Color fundus image, macula-centered: 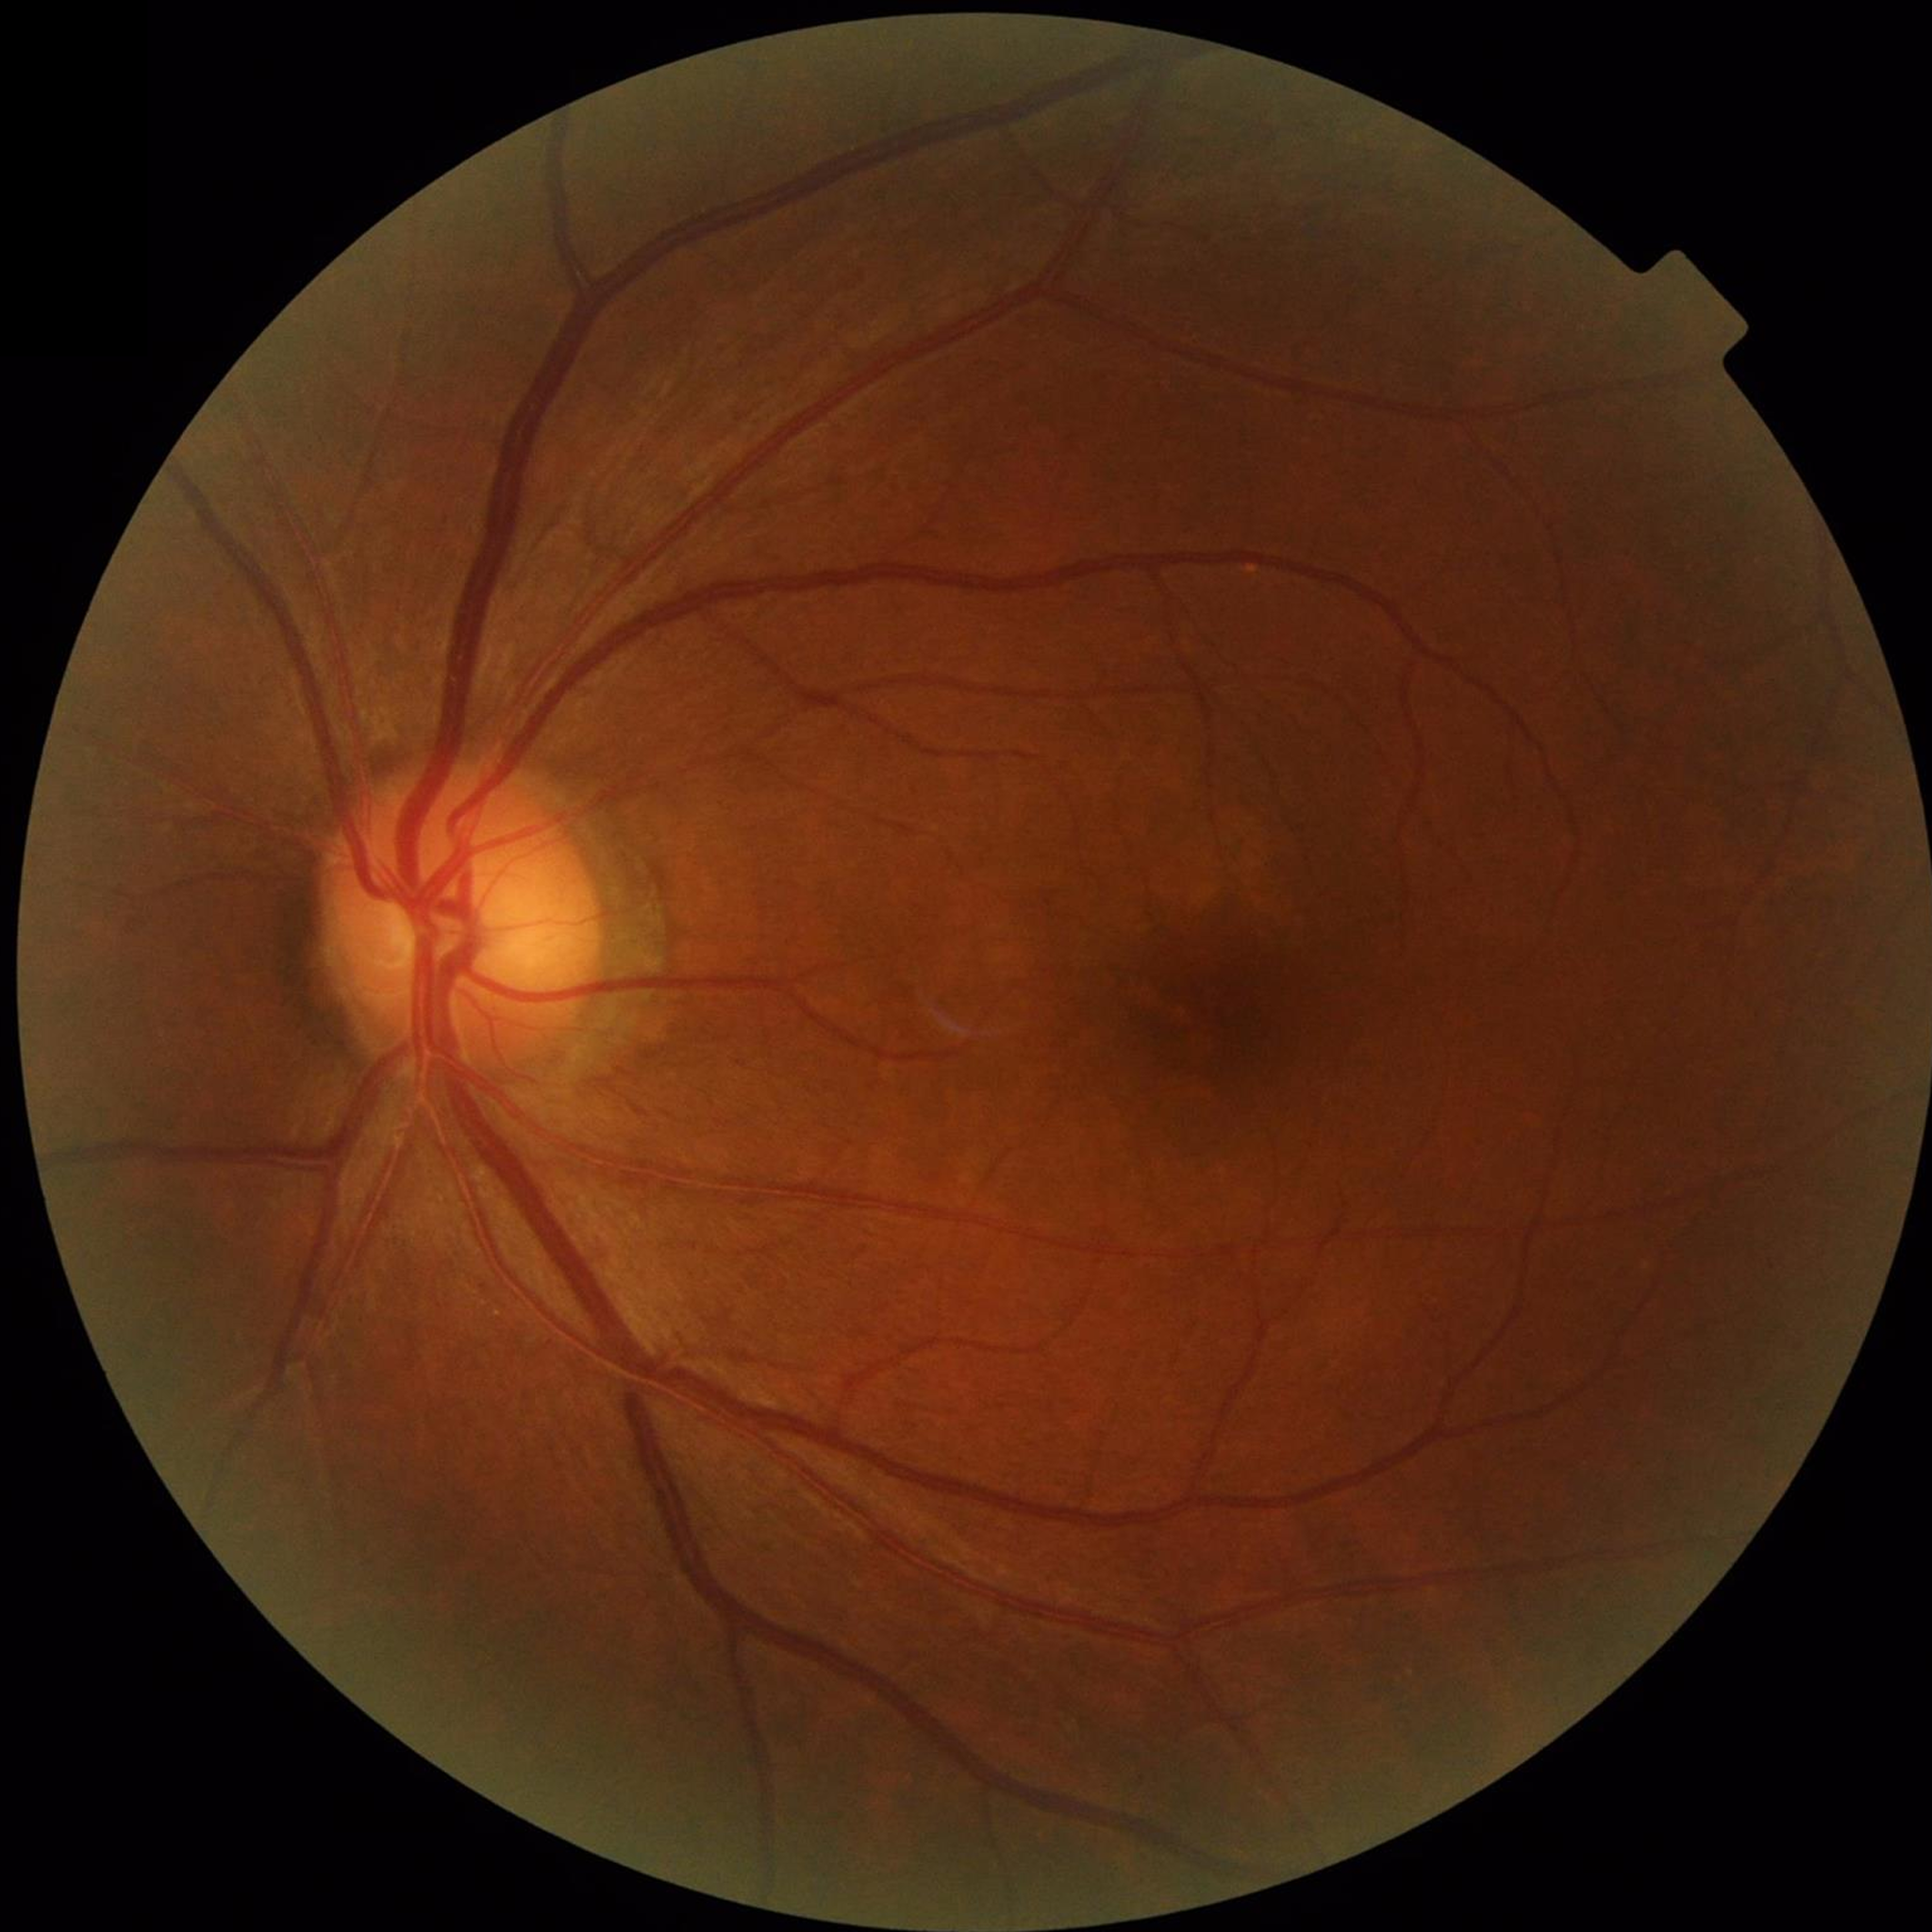 diagnosis: no AMD, diabetic retinopathy, or glaucoma
image_quality: good